Wide-field contact fundus photograph of an infant: 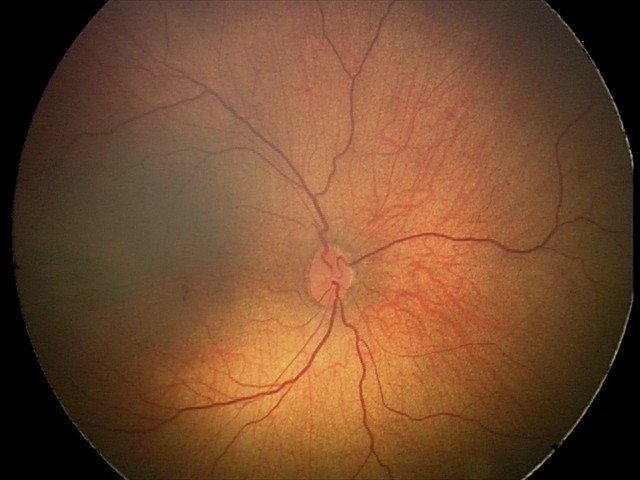

Assessment: normal